Image size 848x848.
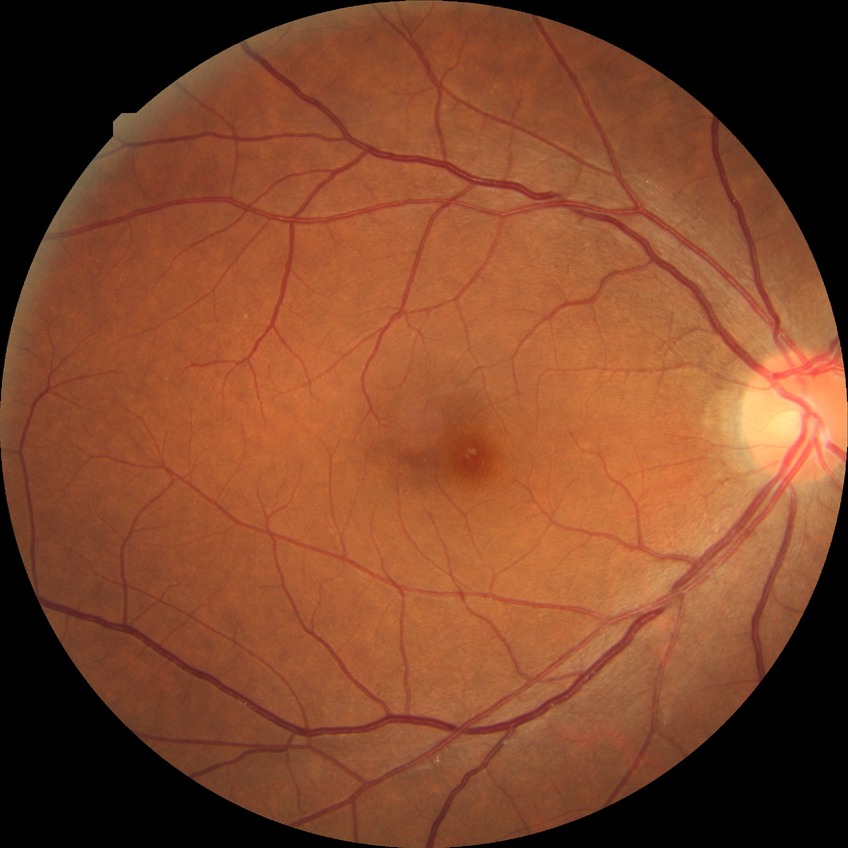 diabetic retinopathy (DR)=NDR (no diabetic retinopathy).